Phoenix ICON, 100° FOV. Infant wide-field fundus photograph.
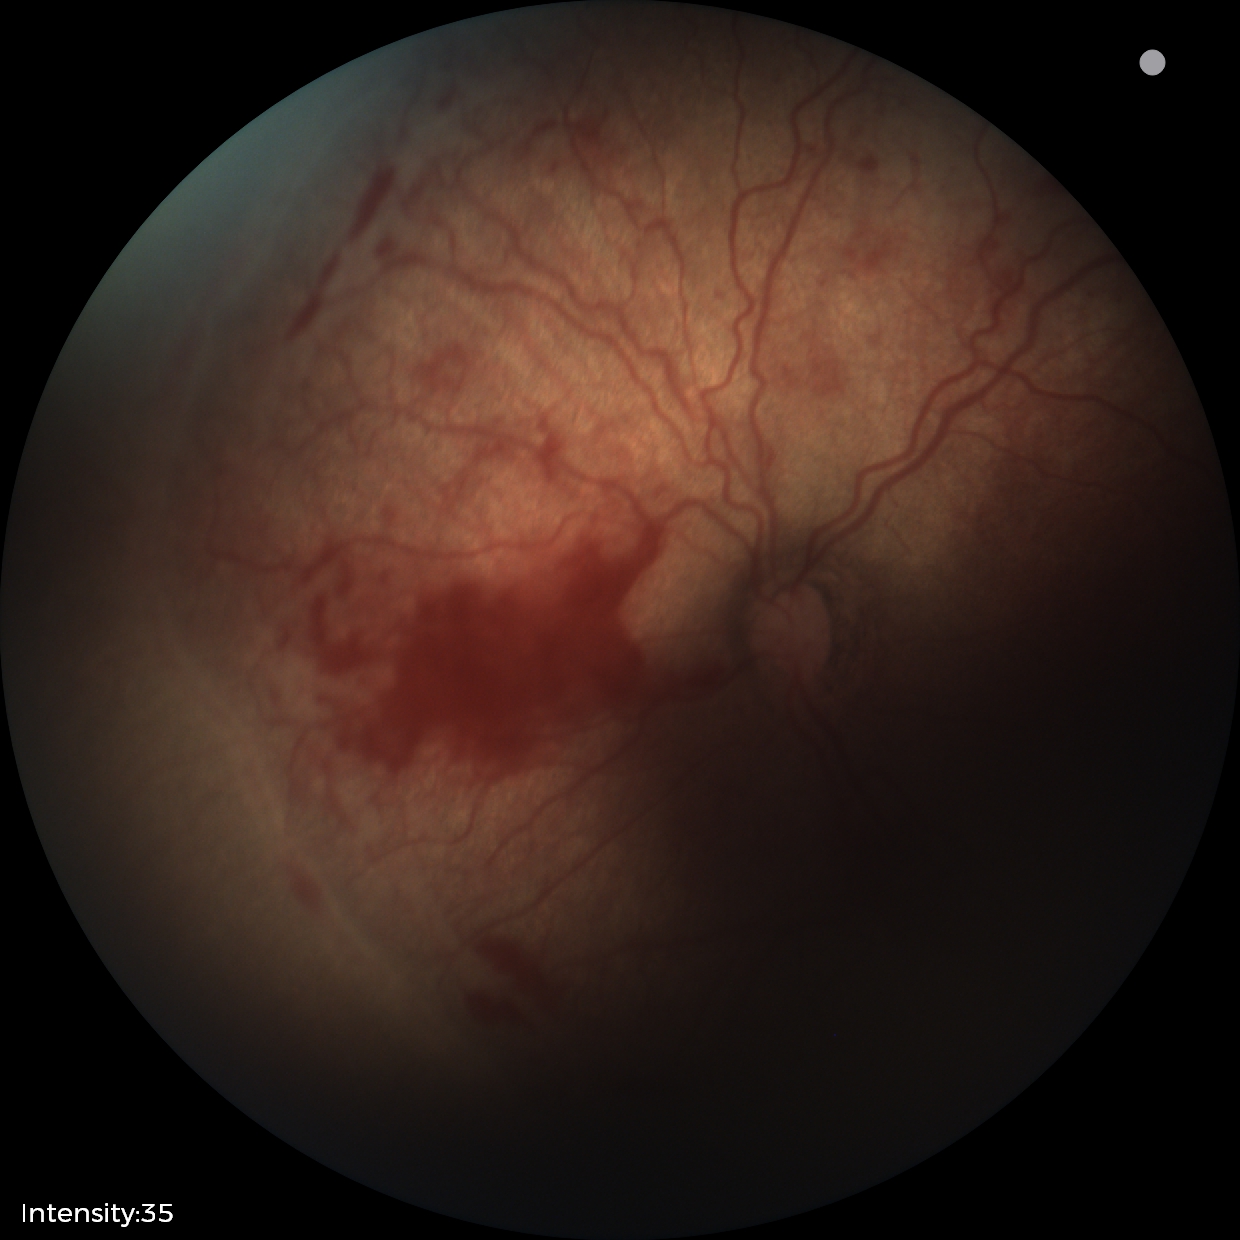

Examination diagnosed as retinopathy of prematurity stage 2.